1380 by 1382 pixels
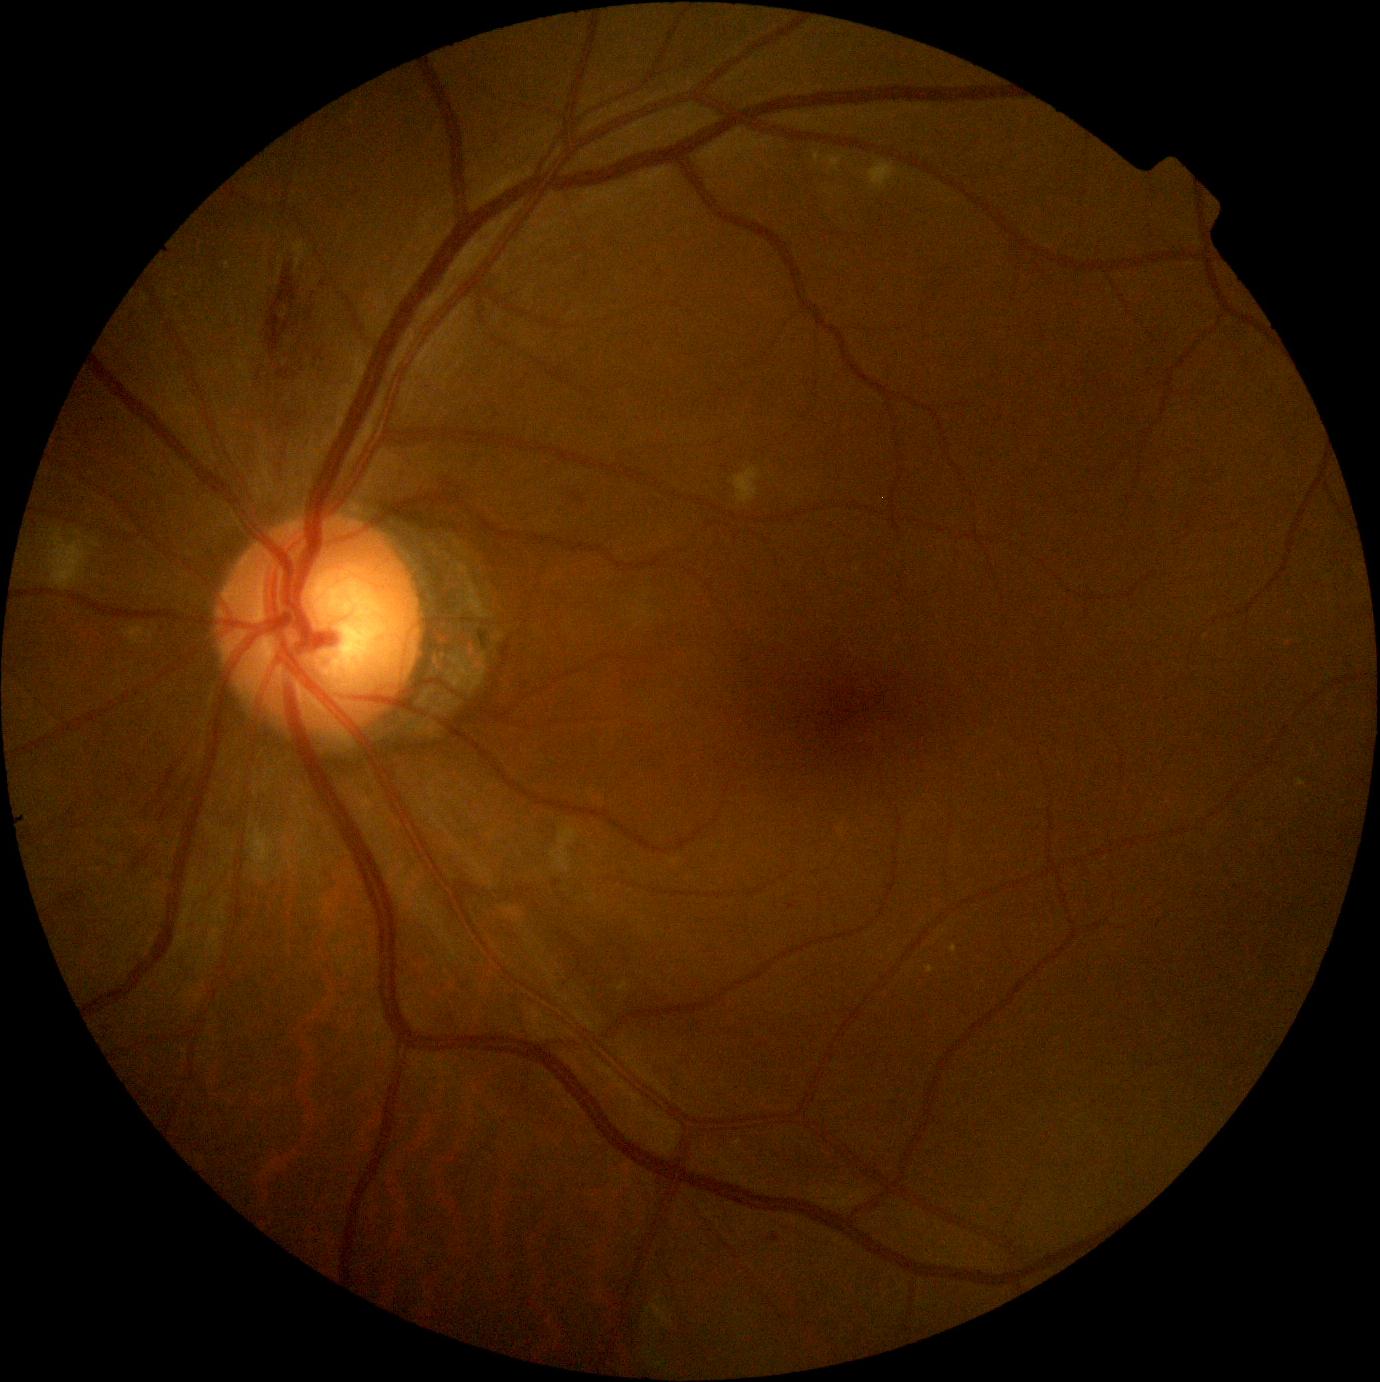 - DR: moderate NPDR (grade 2) — more than just microaneurysms but less than severe NPDR